Modified Davis grading — 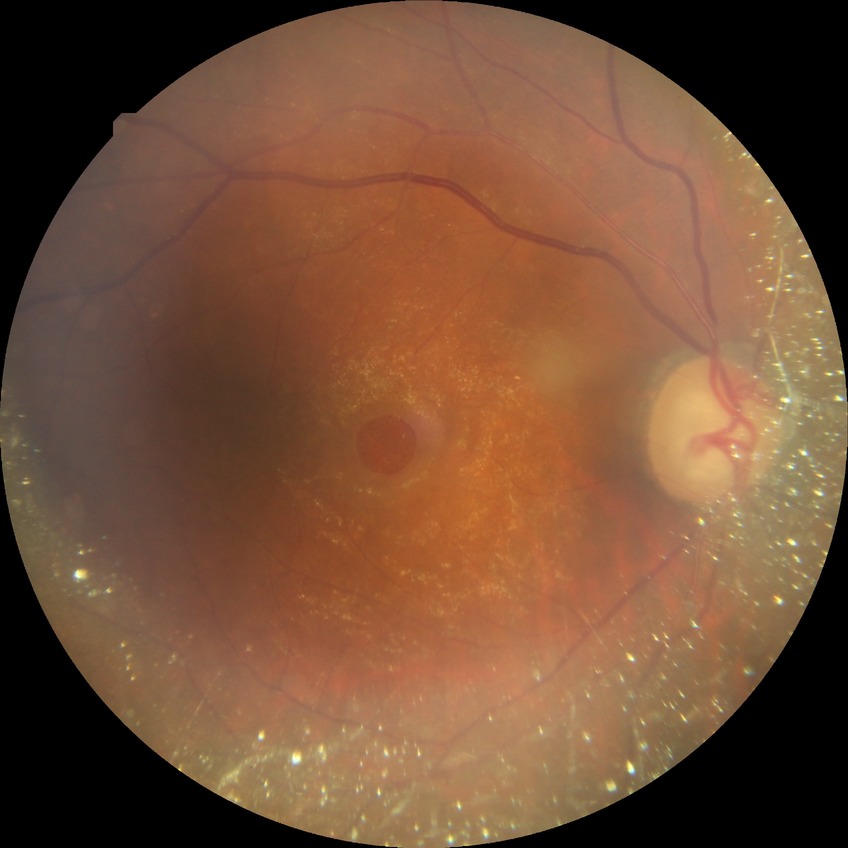 Diabetic retinopathy (DR): no diabetic retinopathy (NDR).